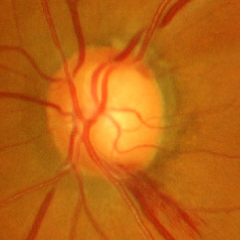

Findings consistent with glaucoma. Glaucoma diagnosis = advanced glaucomatous optic neuropathy.